2352x1568
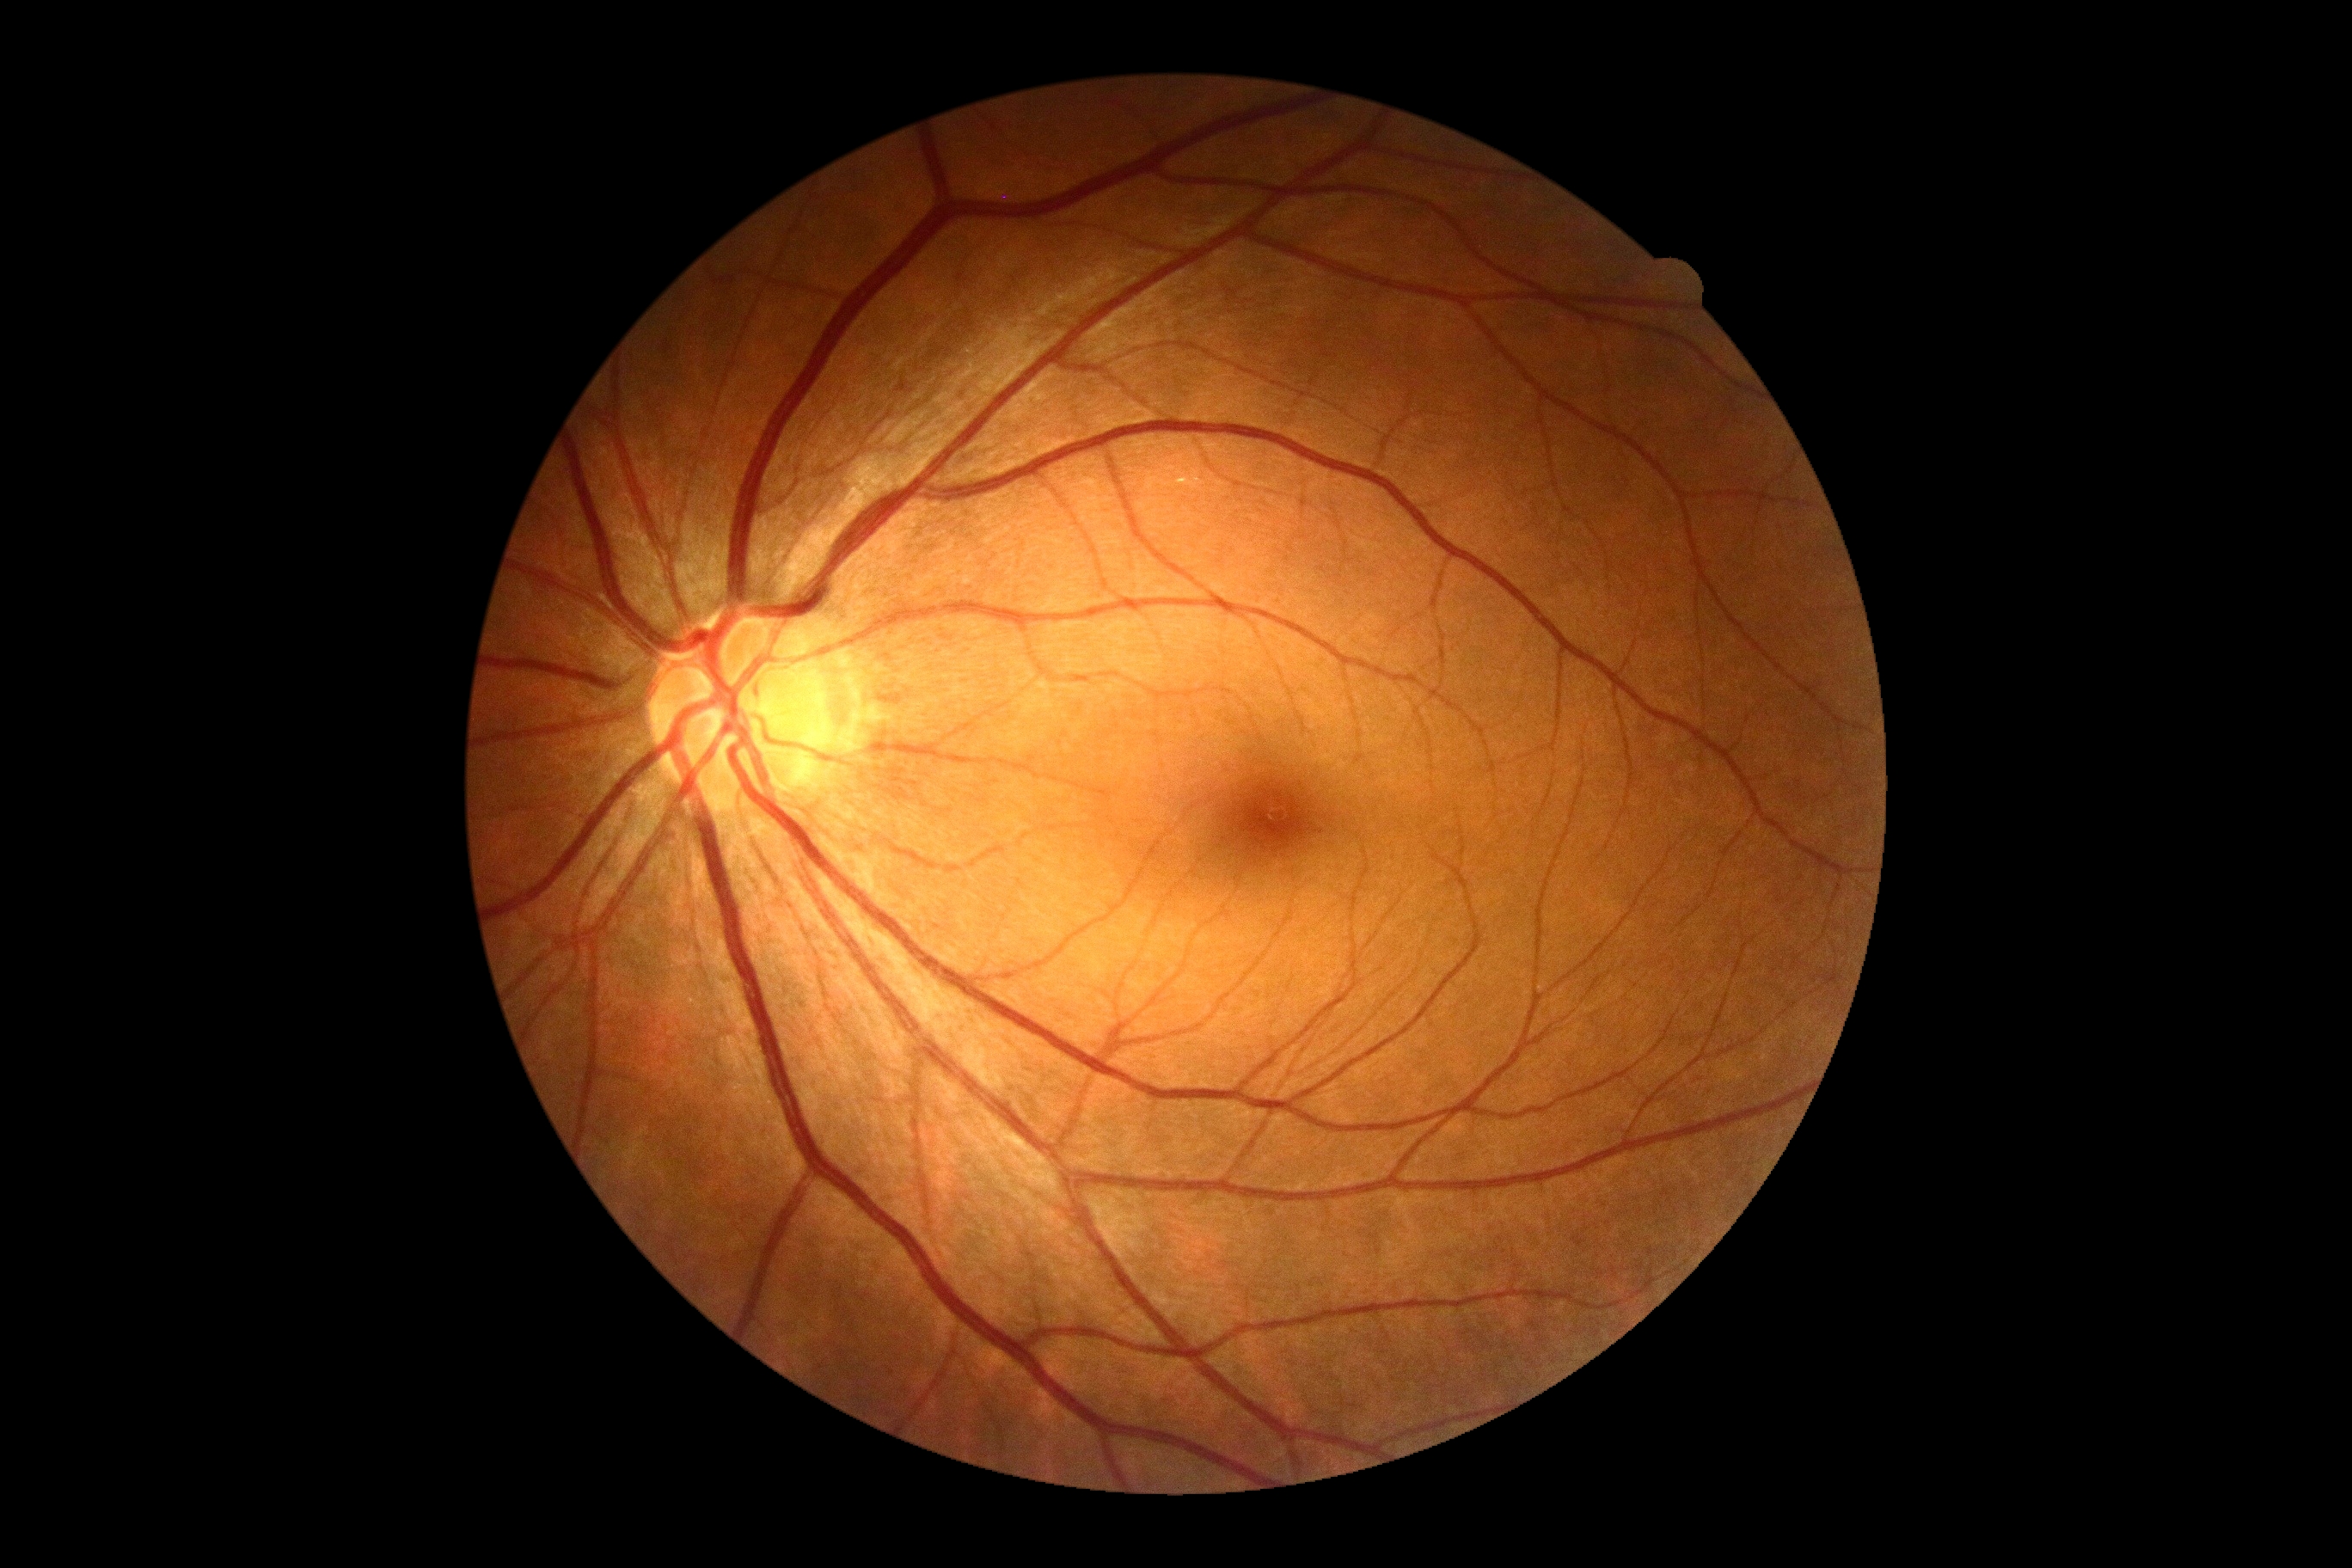
No DR findings.
Diabetic retinopathy (DR) is grade 0.